Fundus photo — 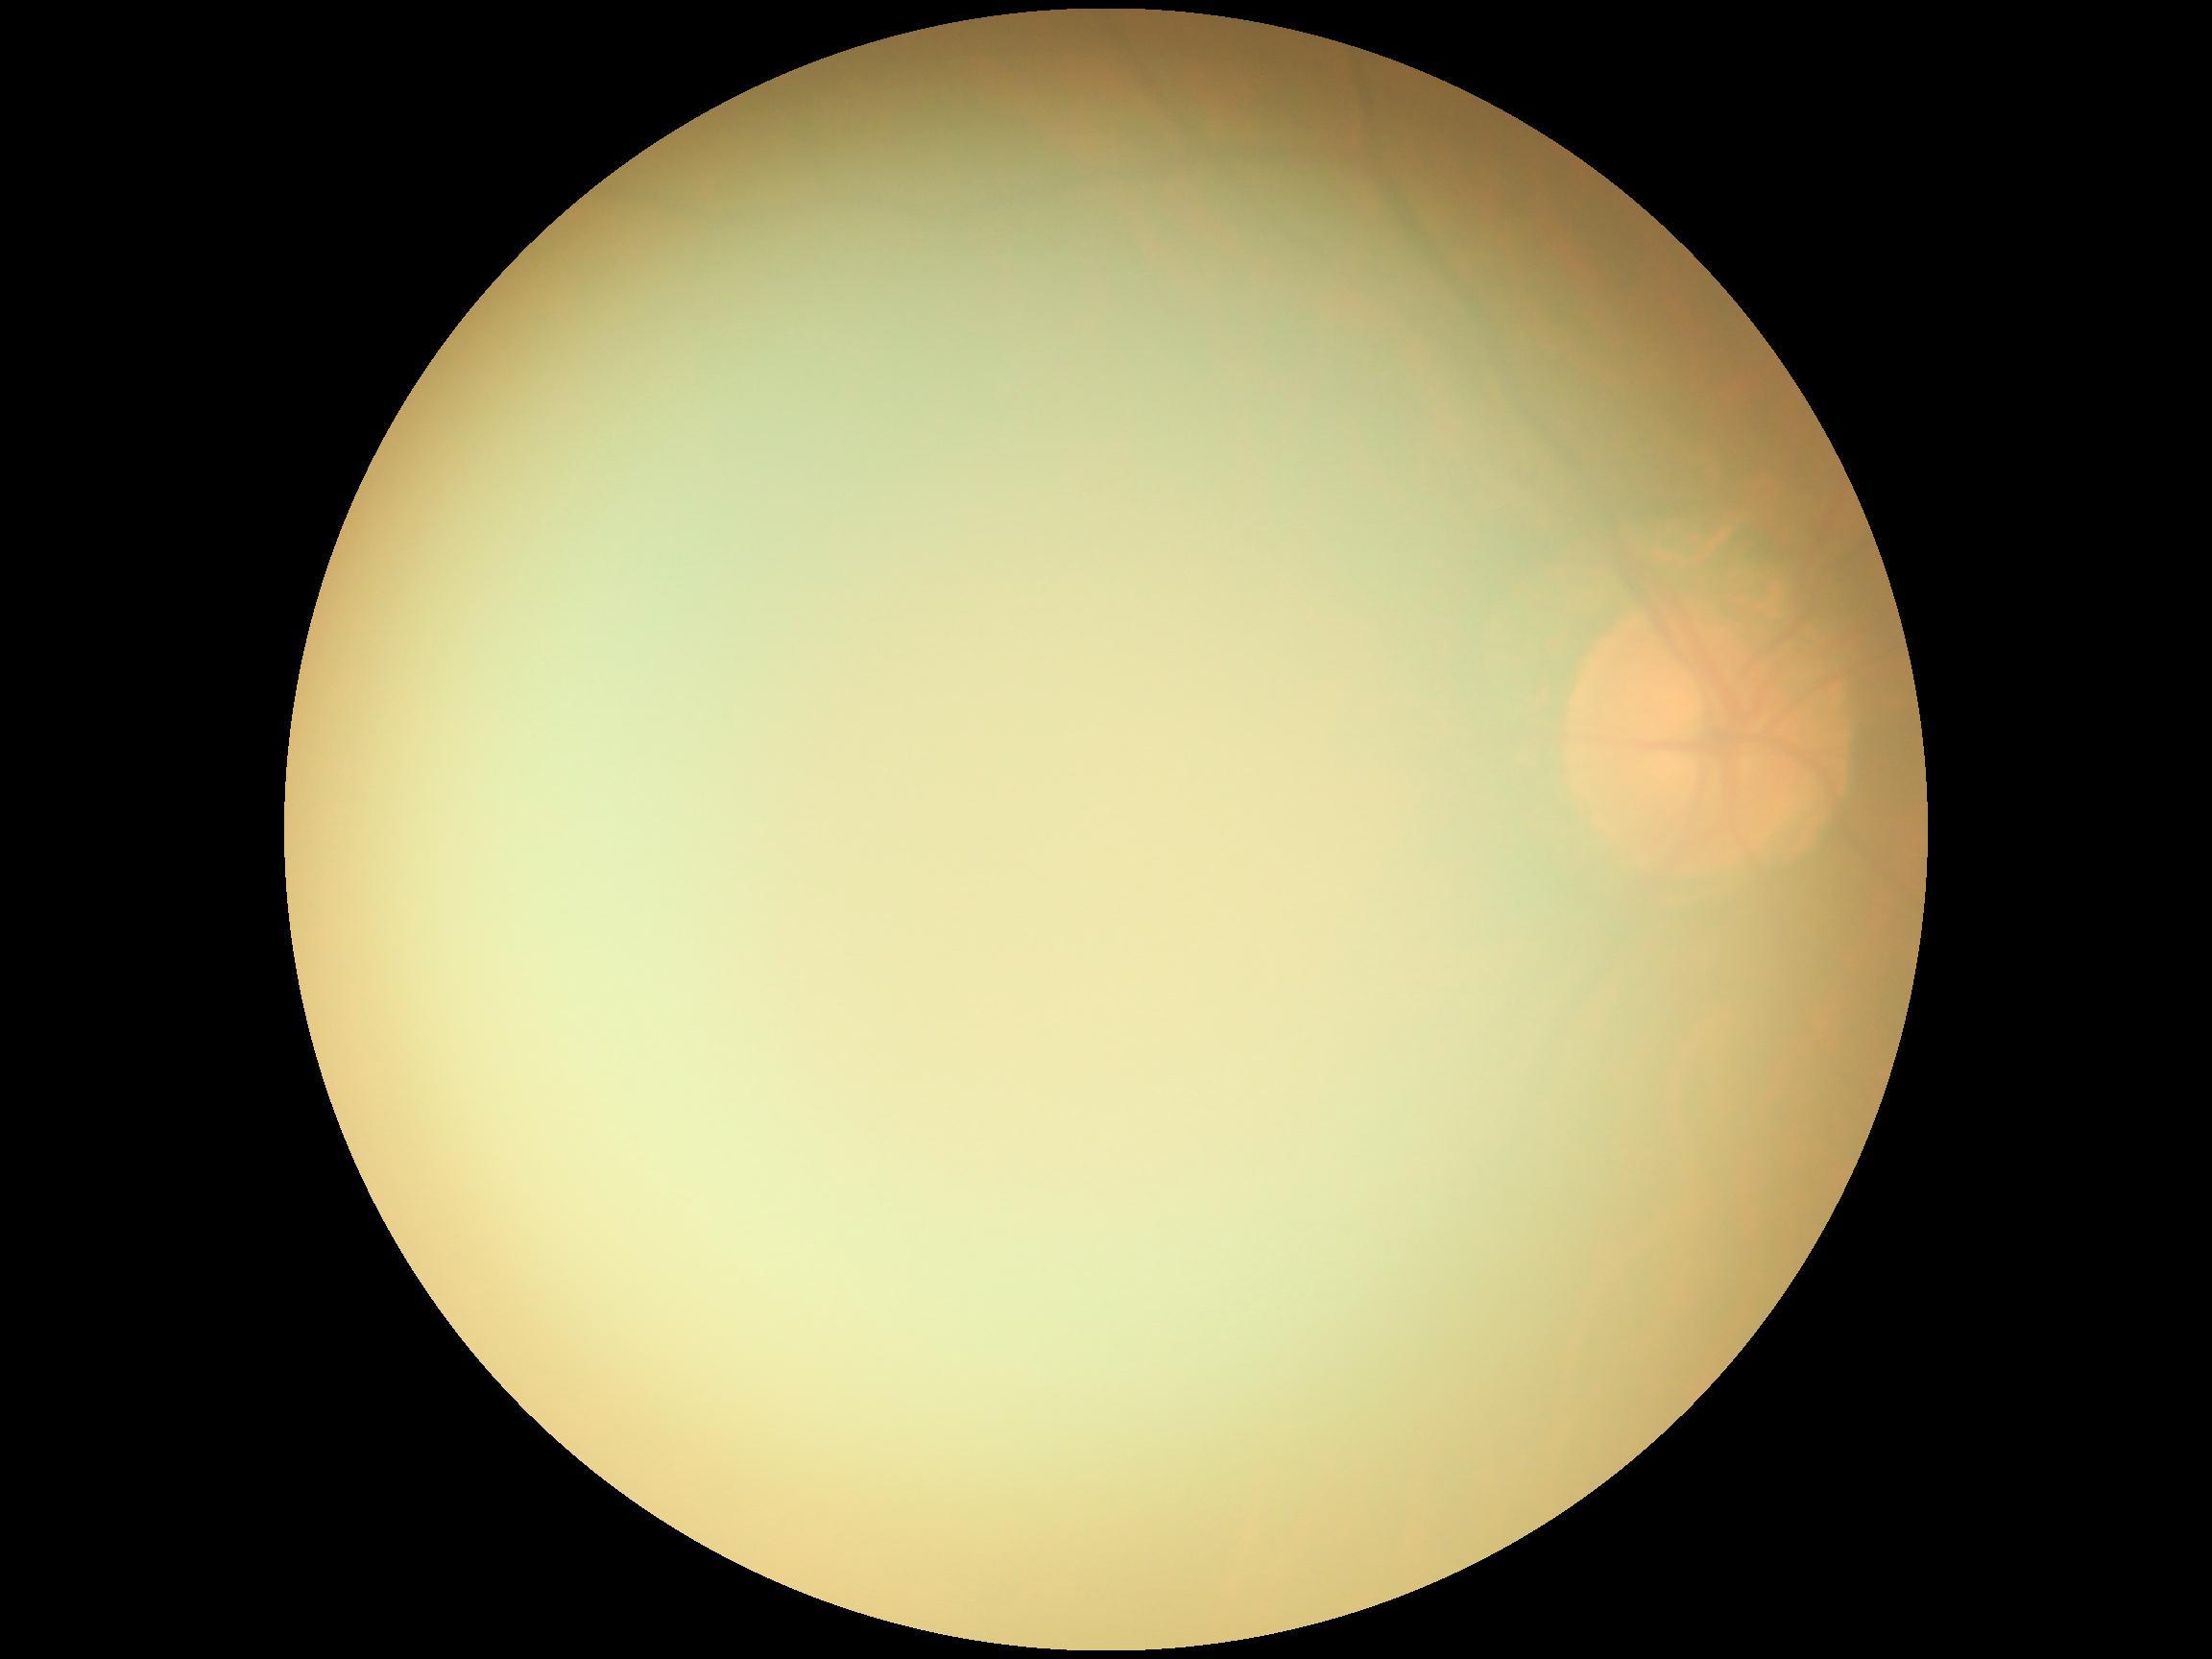 Diabetic retinopathy (DR): ungradable due to poor image quality.